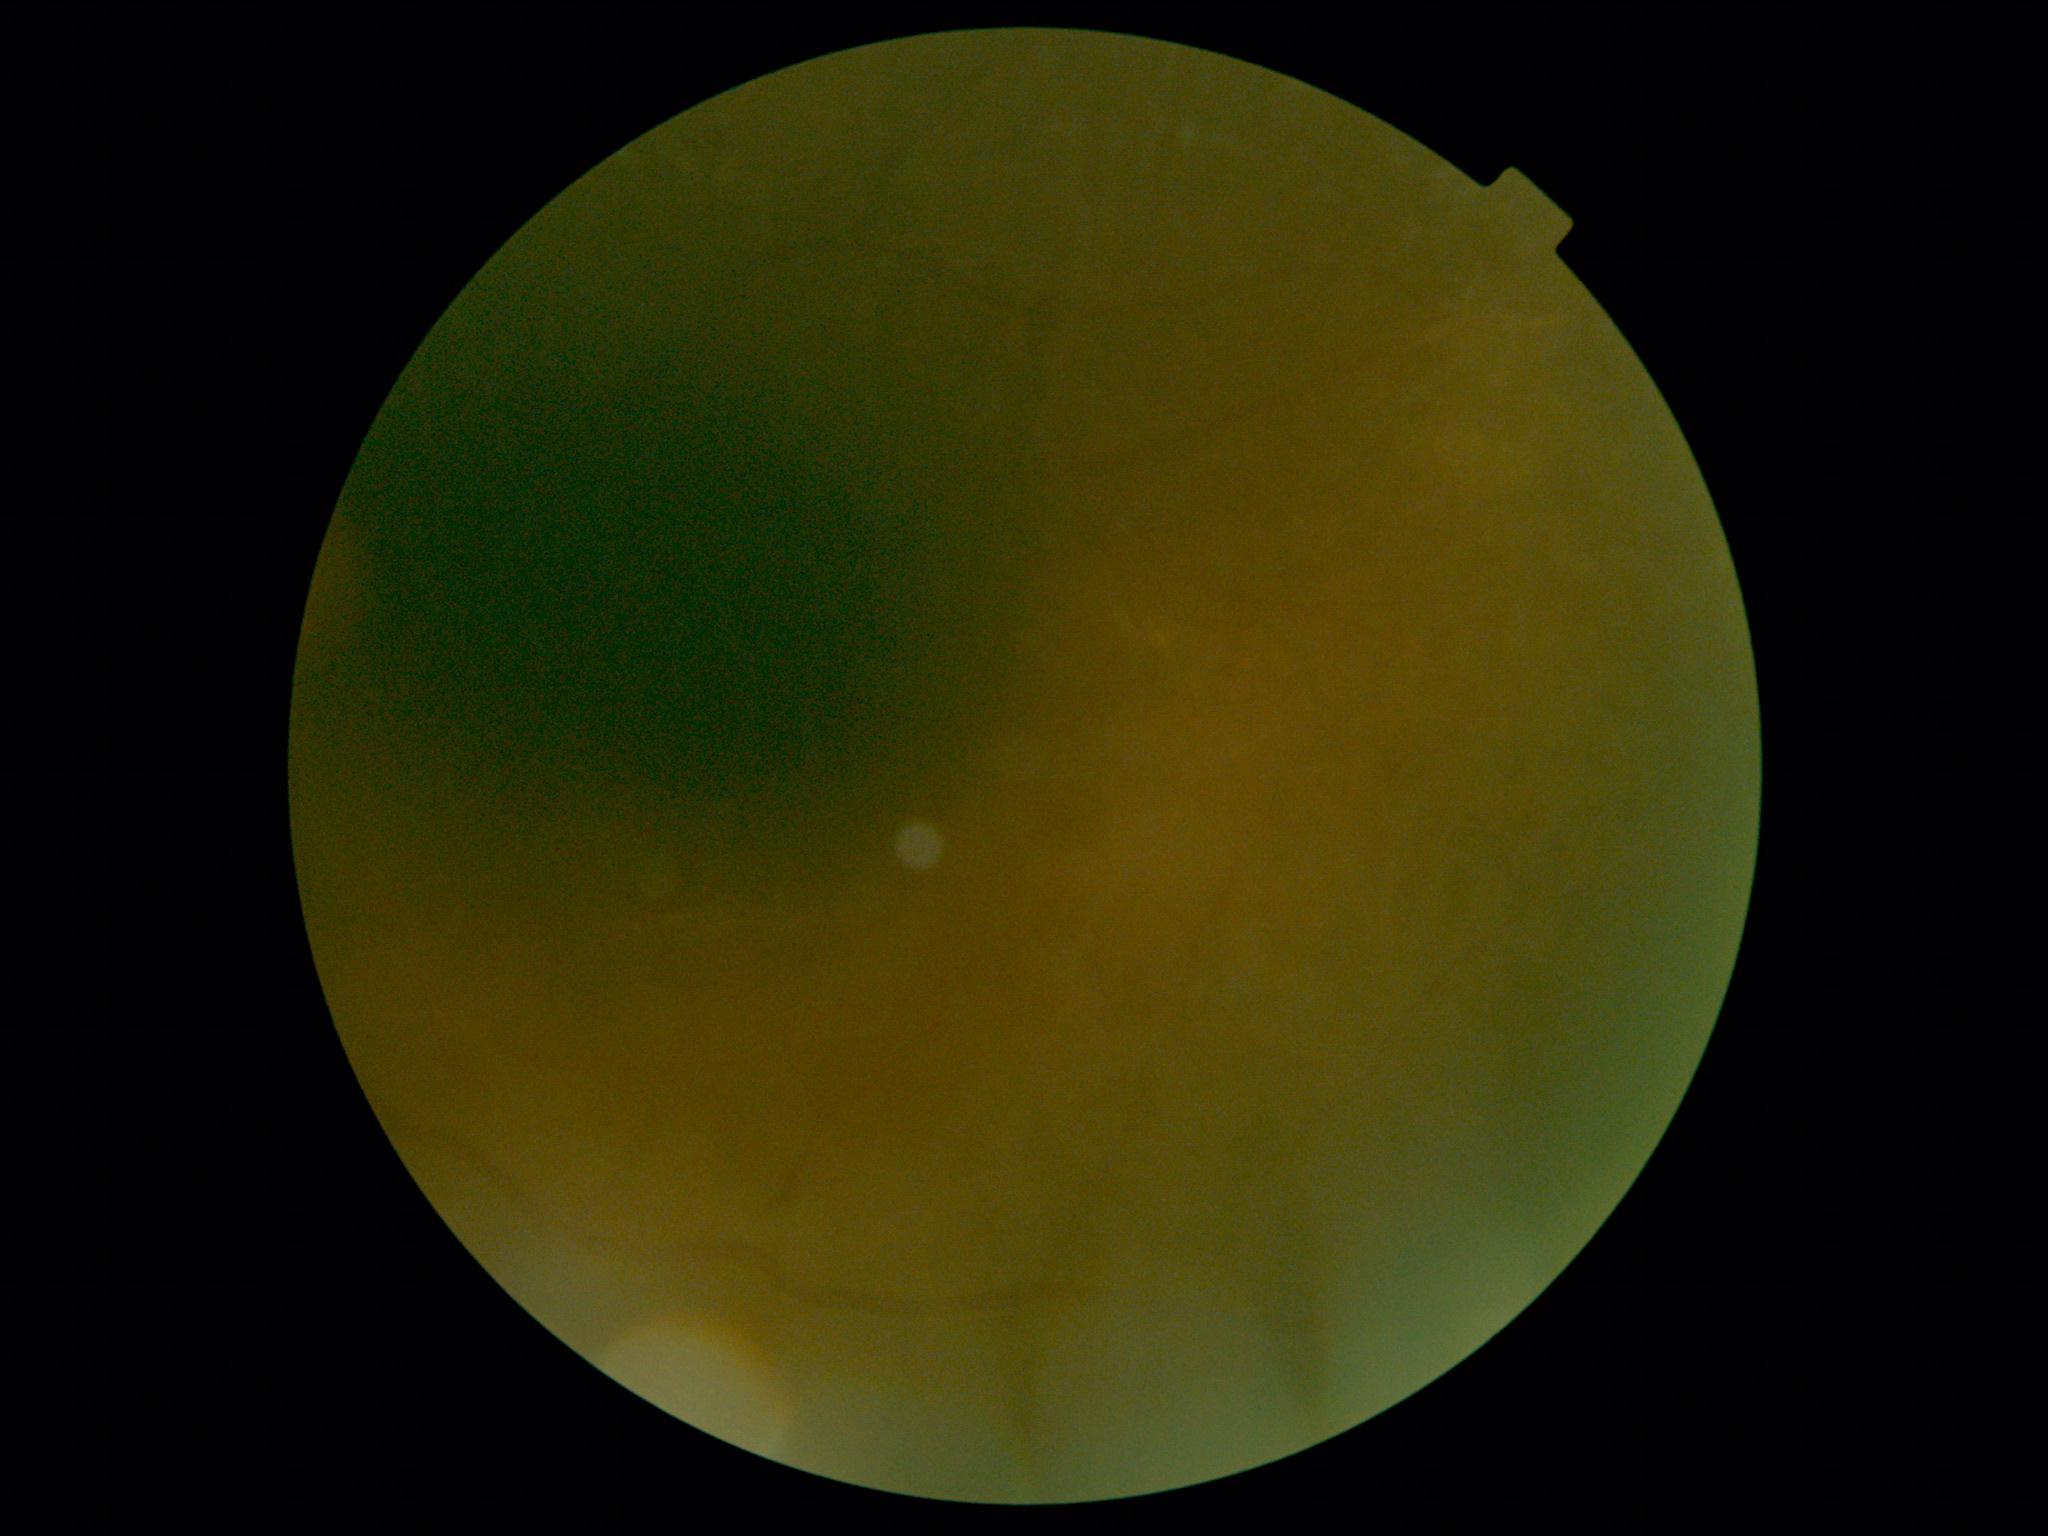 Retinopathy is ungradable due to poor image quality.